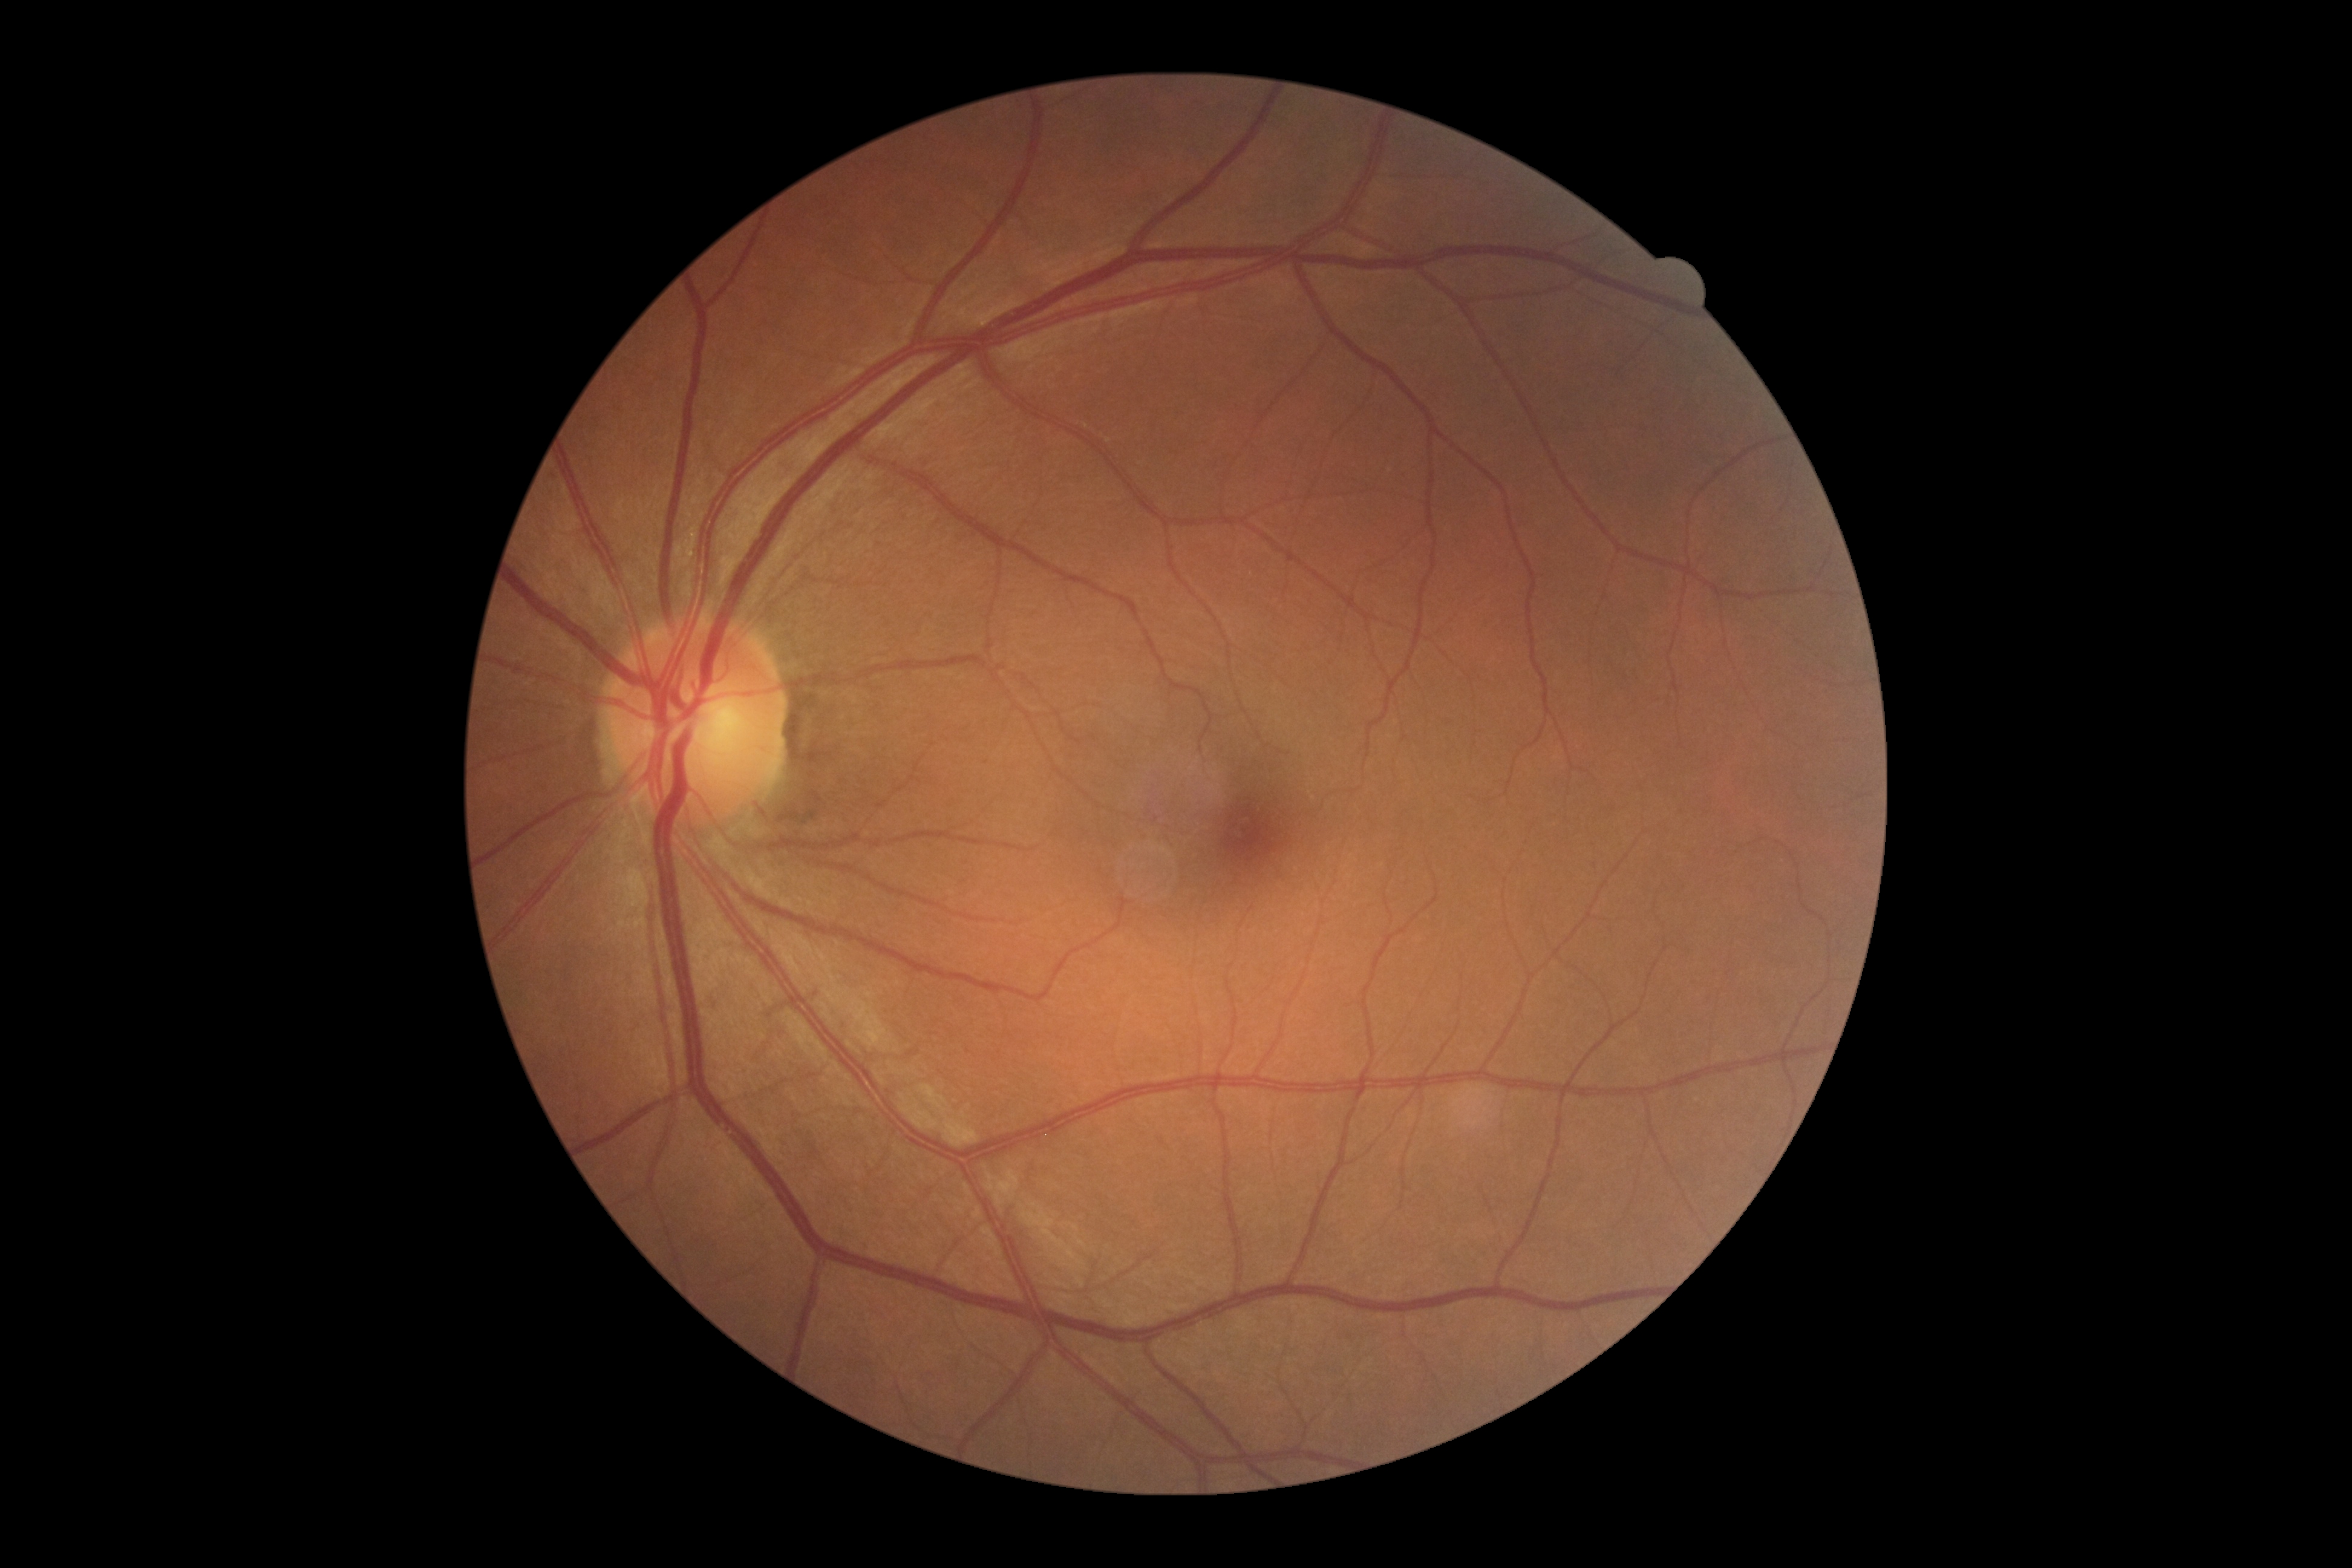

{"dr_grade": "grade 0 (no apparent retinopathy) — no visible signs of diabetic retinopathy"}